Non-mydriatic.
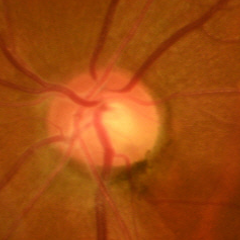

Glaucoma stage = early glaucomatous optic neuropathy.